Pediatric retinal photograph (wide-field):
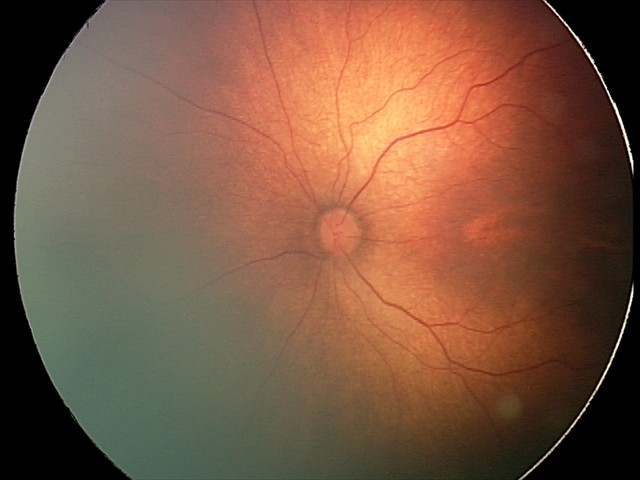 No plus disease.
Examination diagnosed as status post retinopathy of prematurity.